Infant wide-field fundus photograph; image size 640x480
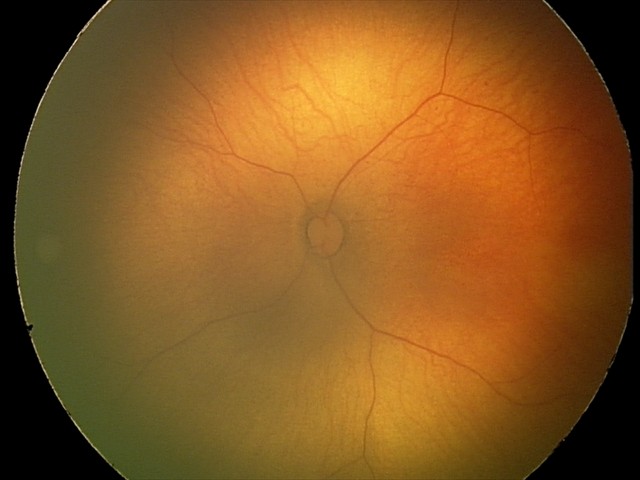 Physiological retinal appearance for postconceptual age.